Wide-field contact fundus photograph of an infant:
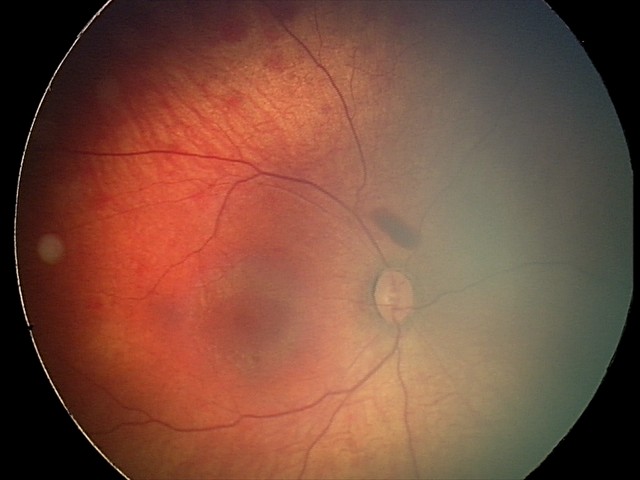 Screening examination consistent with retinal hemorrhages.